2346 by 1568 pixels · color fundus image: 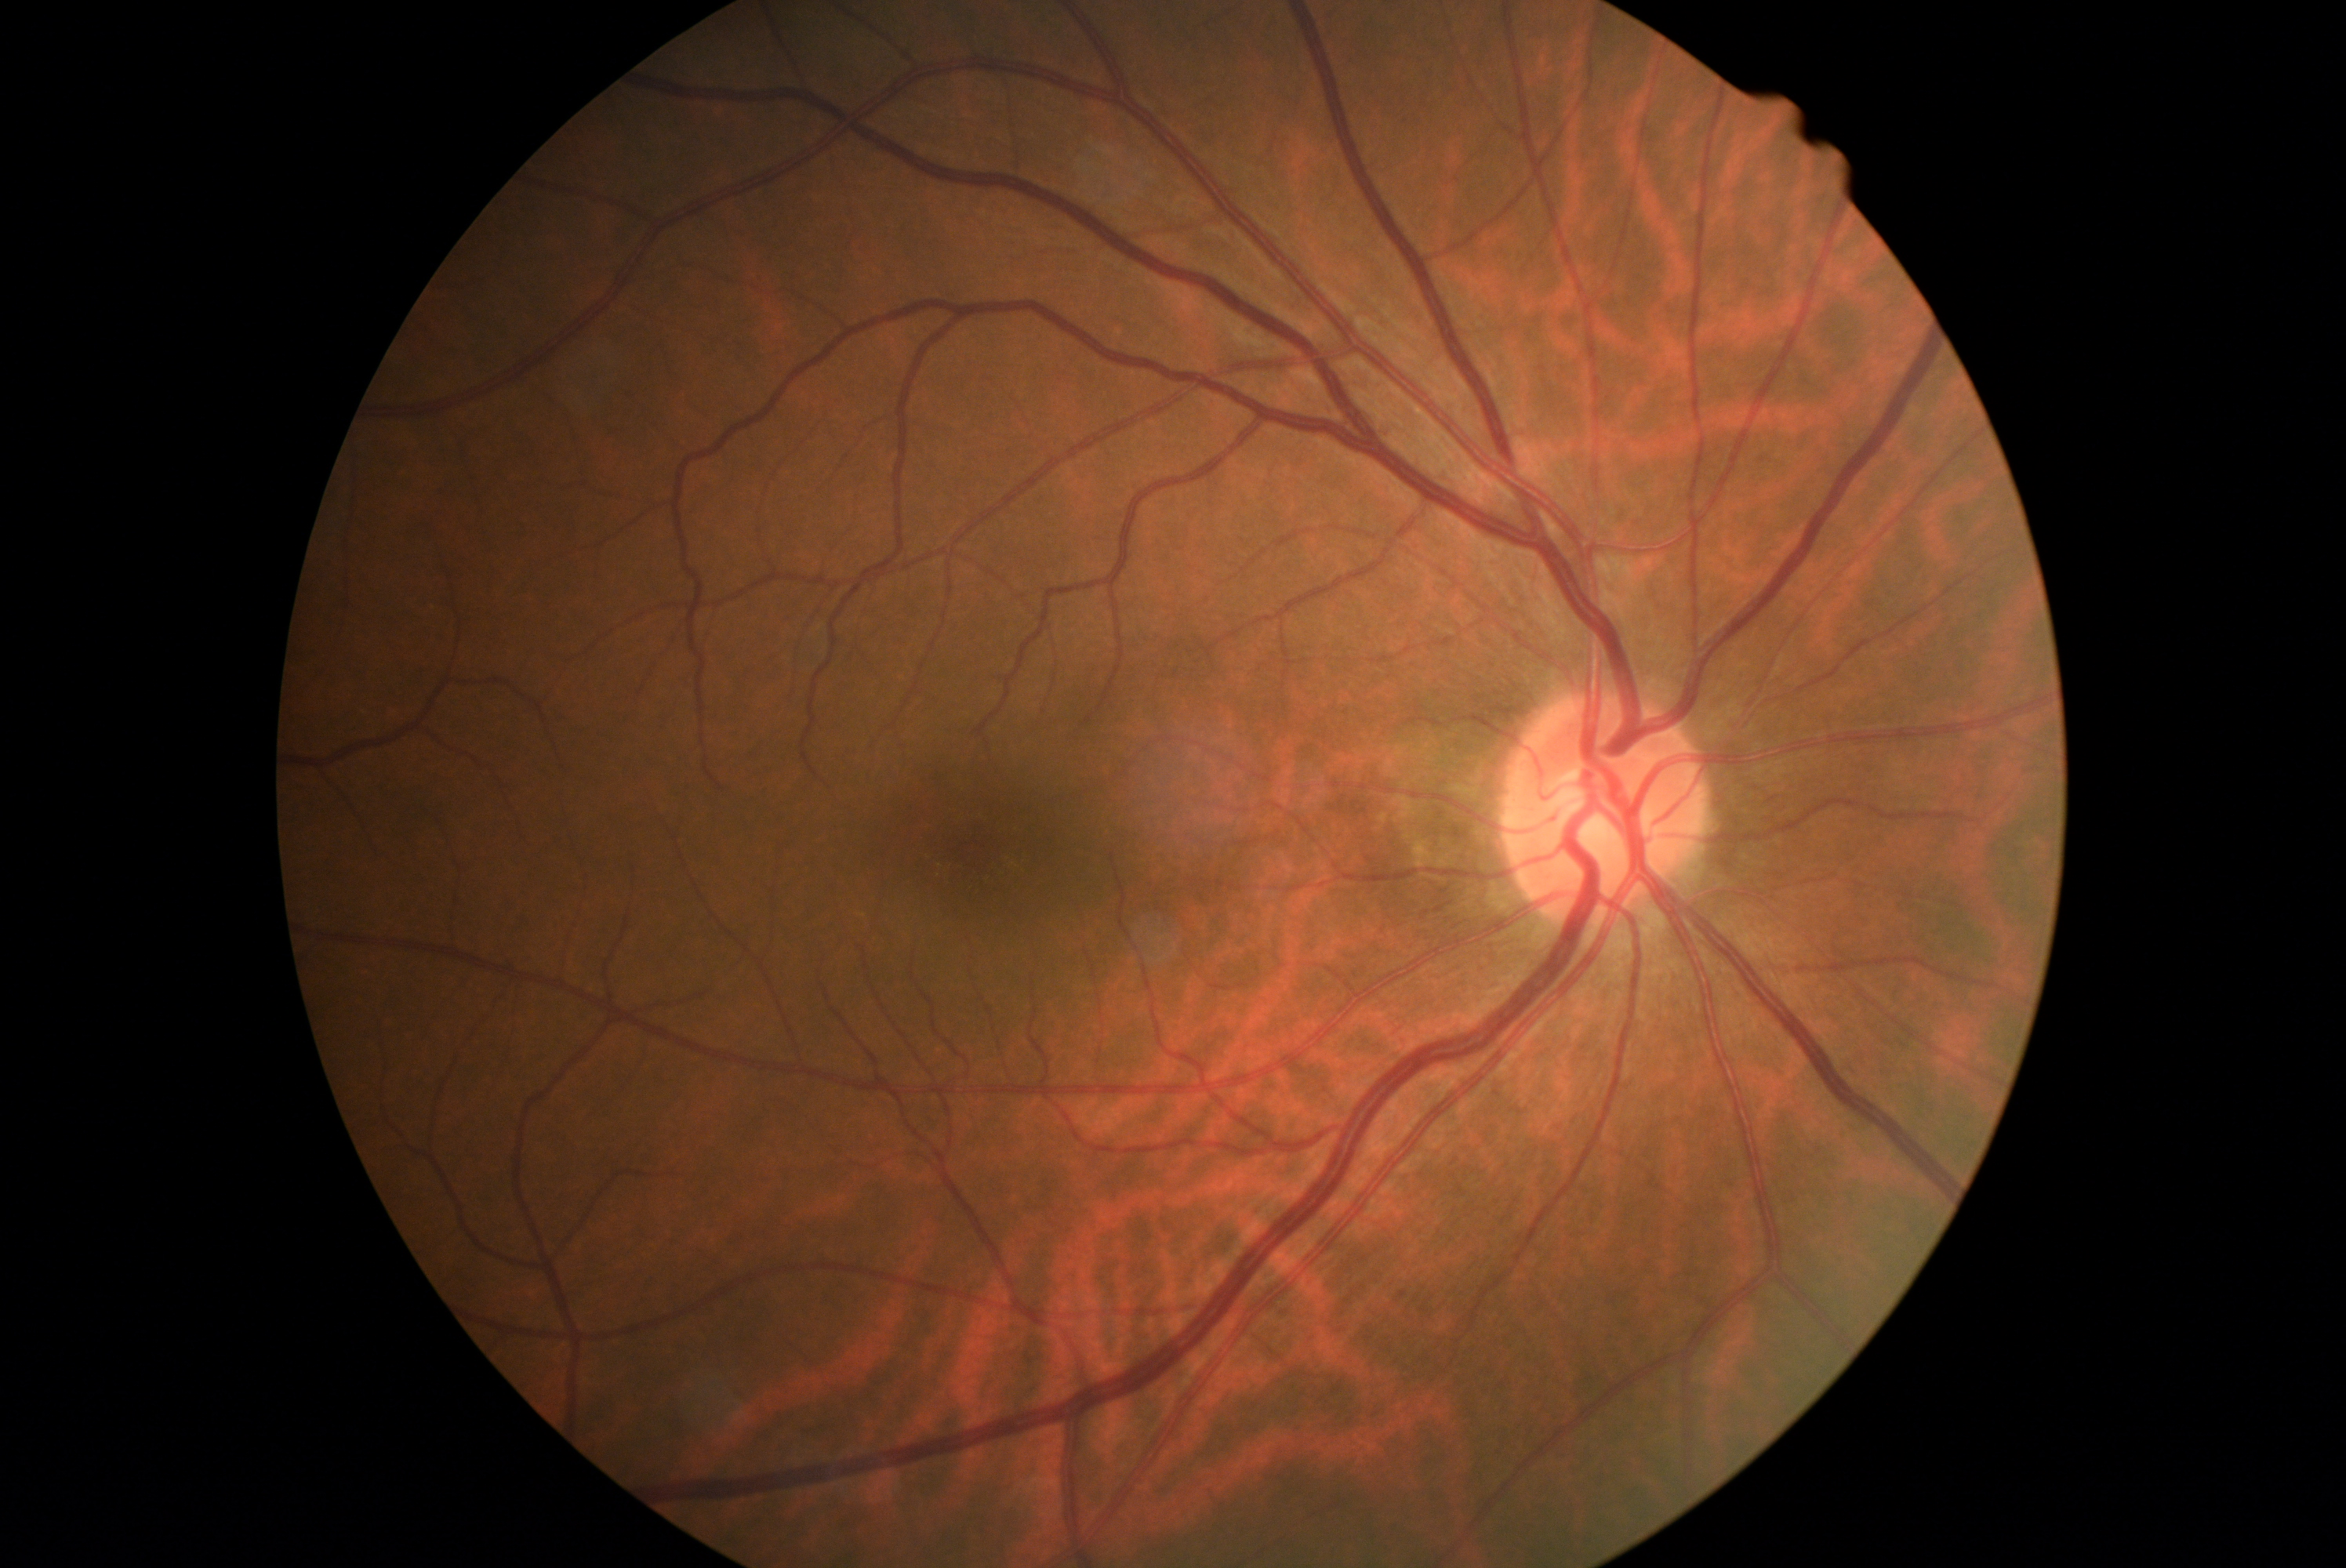
No diabetic retinal disease findings. Diabetic retinopathy (DR): 0.